CFP. Without pupil dilation: 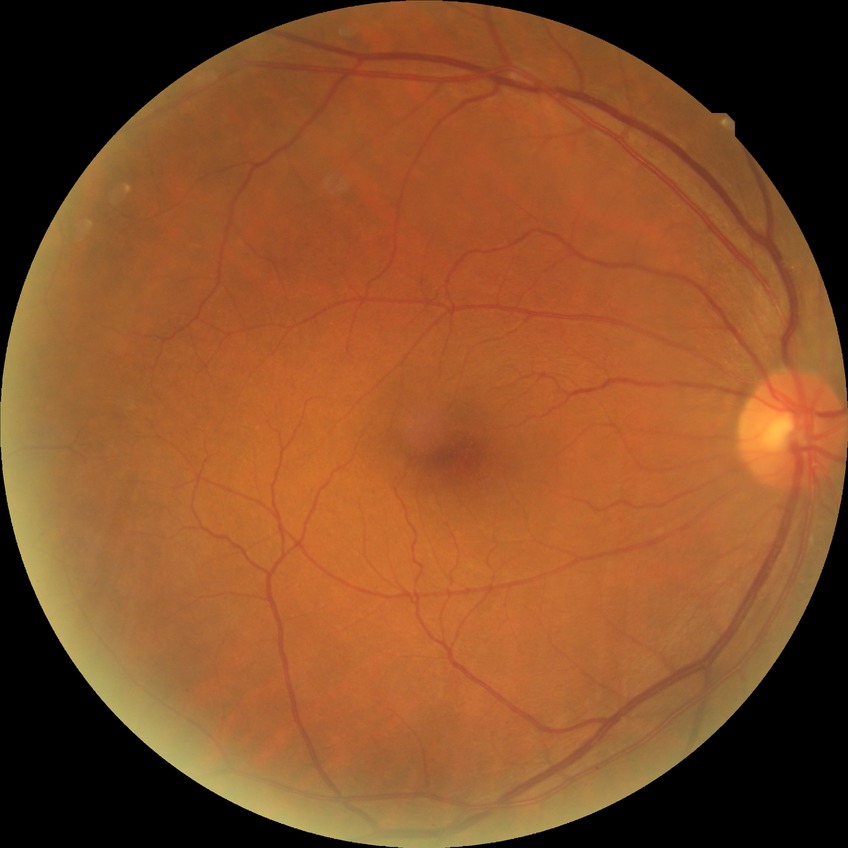 dr_impression: no signs of DR
davis_grade: NDR